45° FOV: 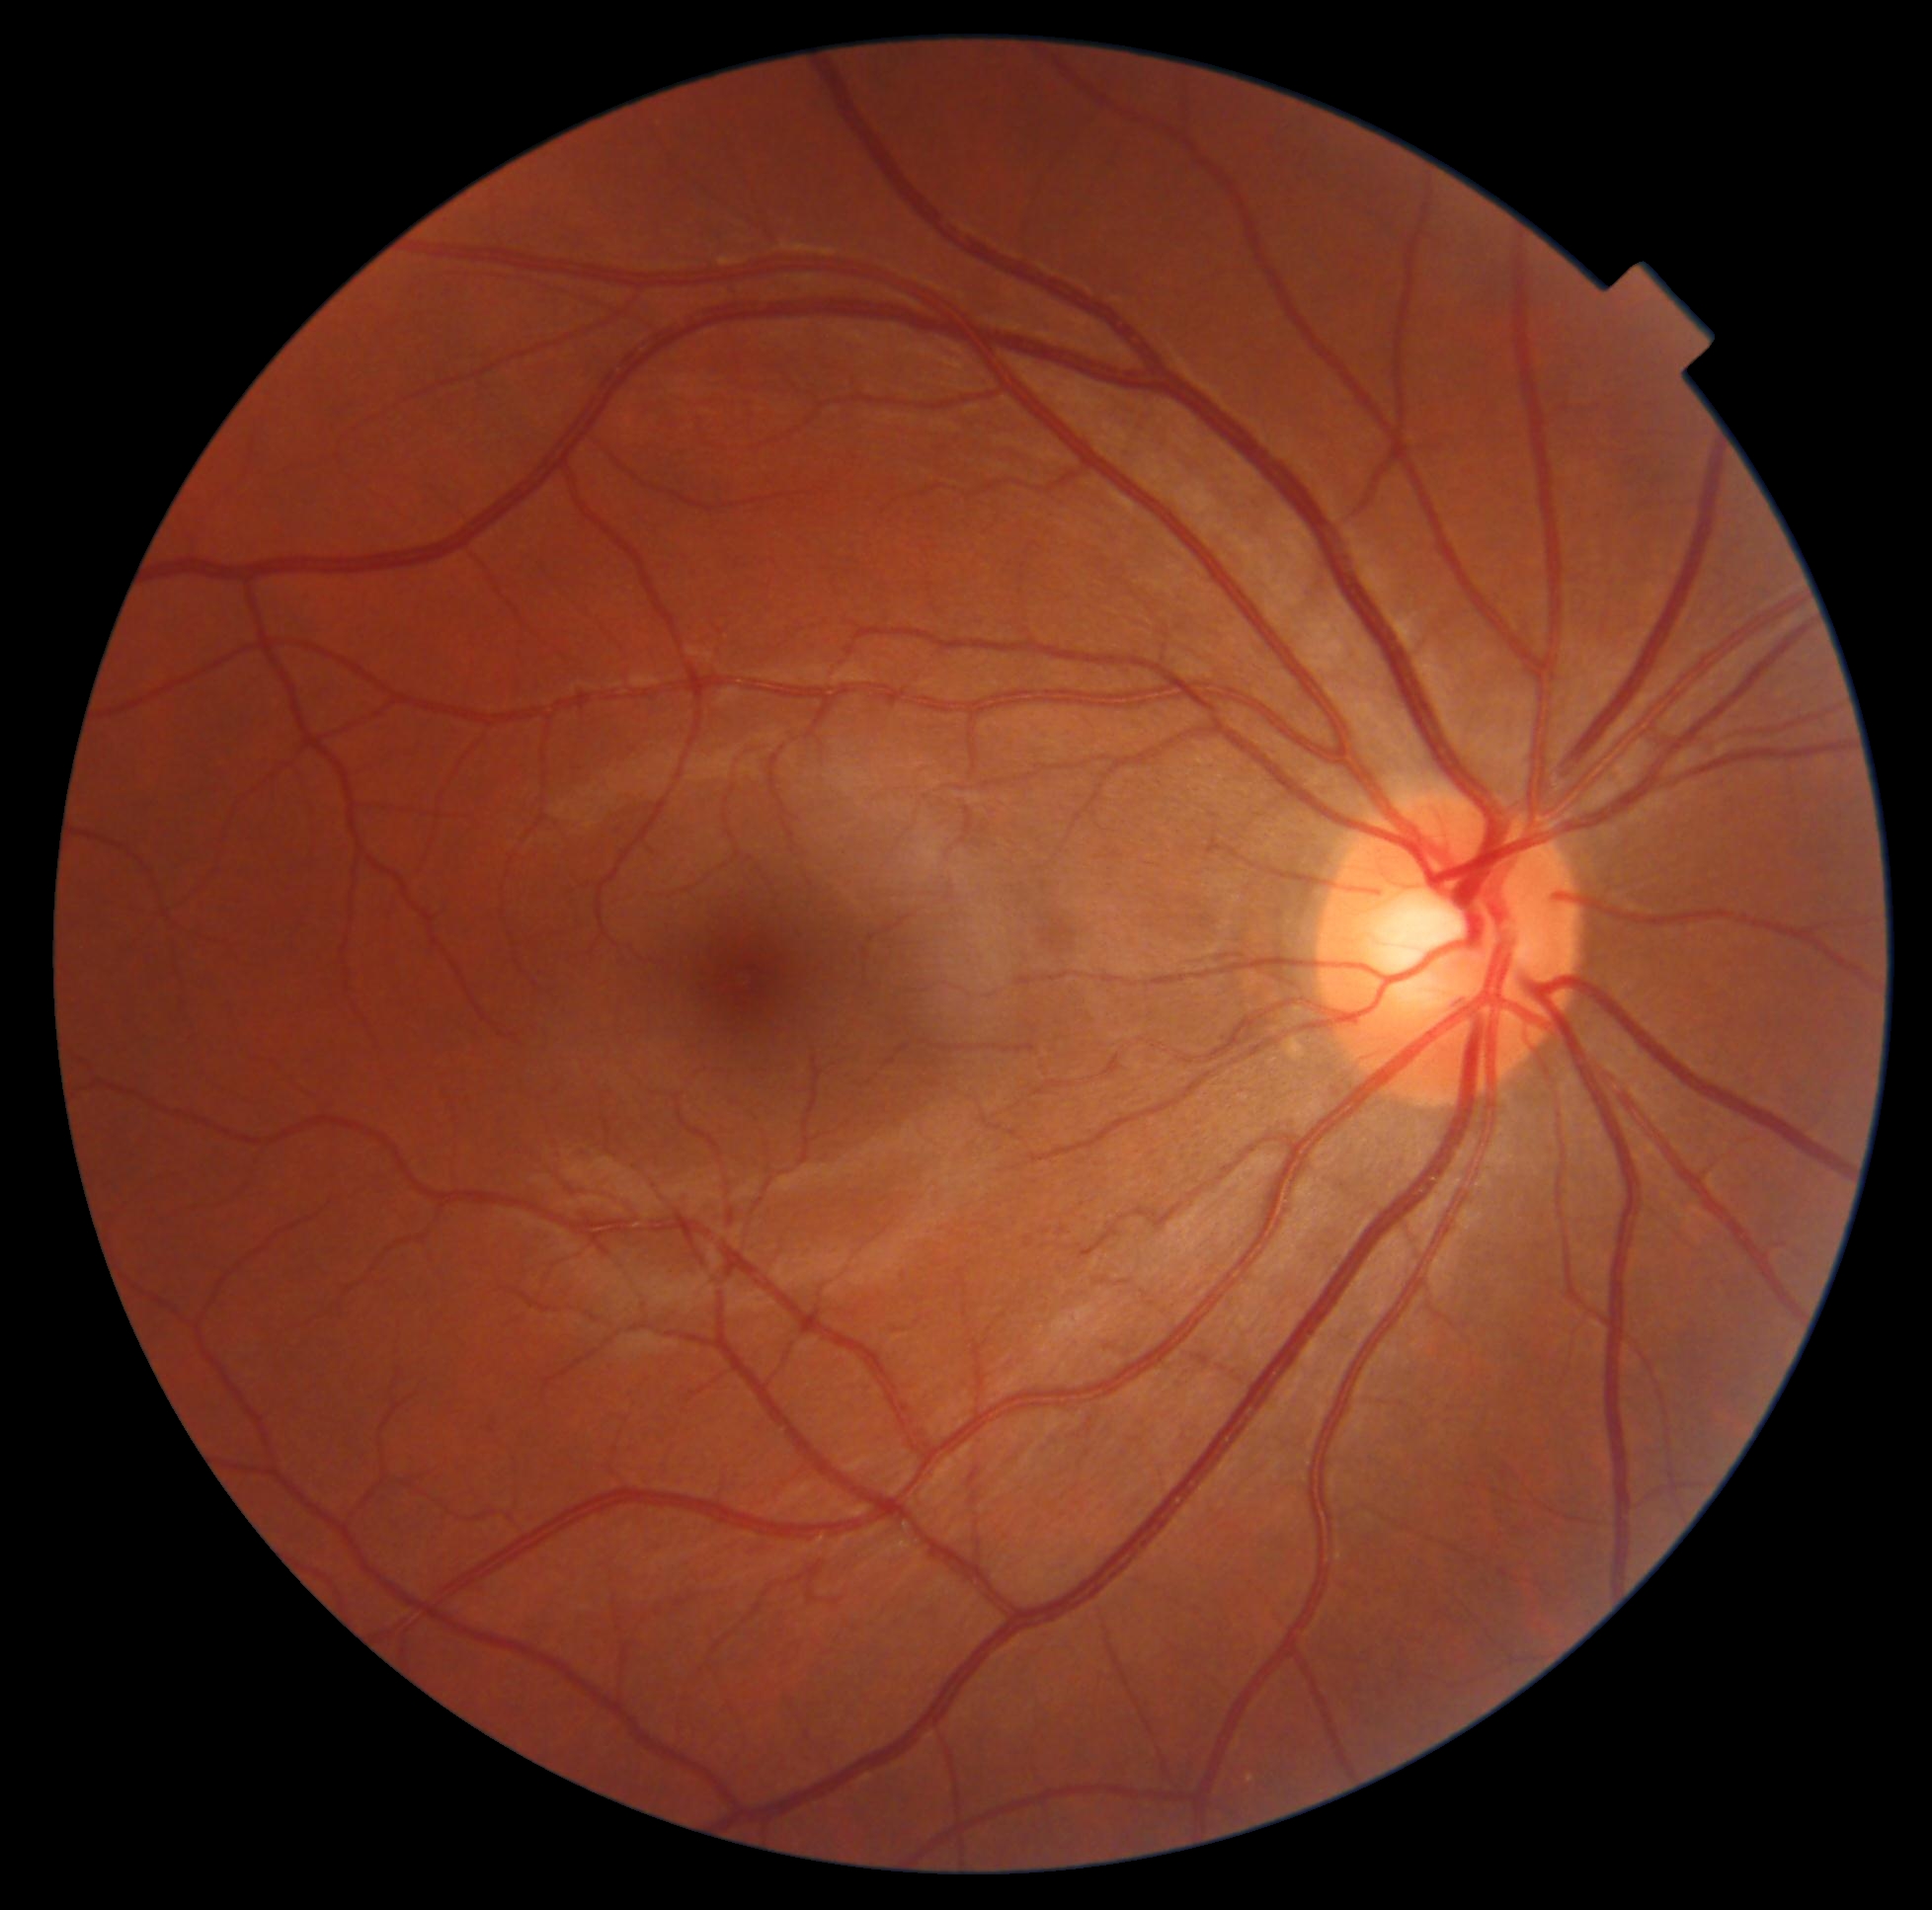

DR@grade 0 (no apparent retinopathy).